45° field of view — 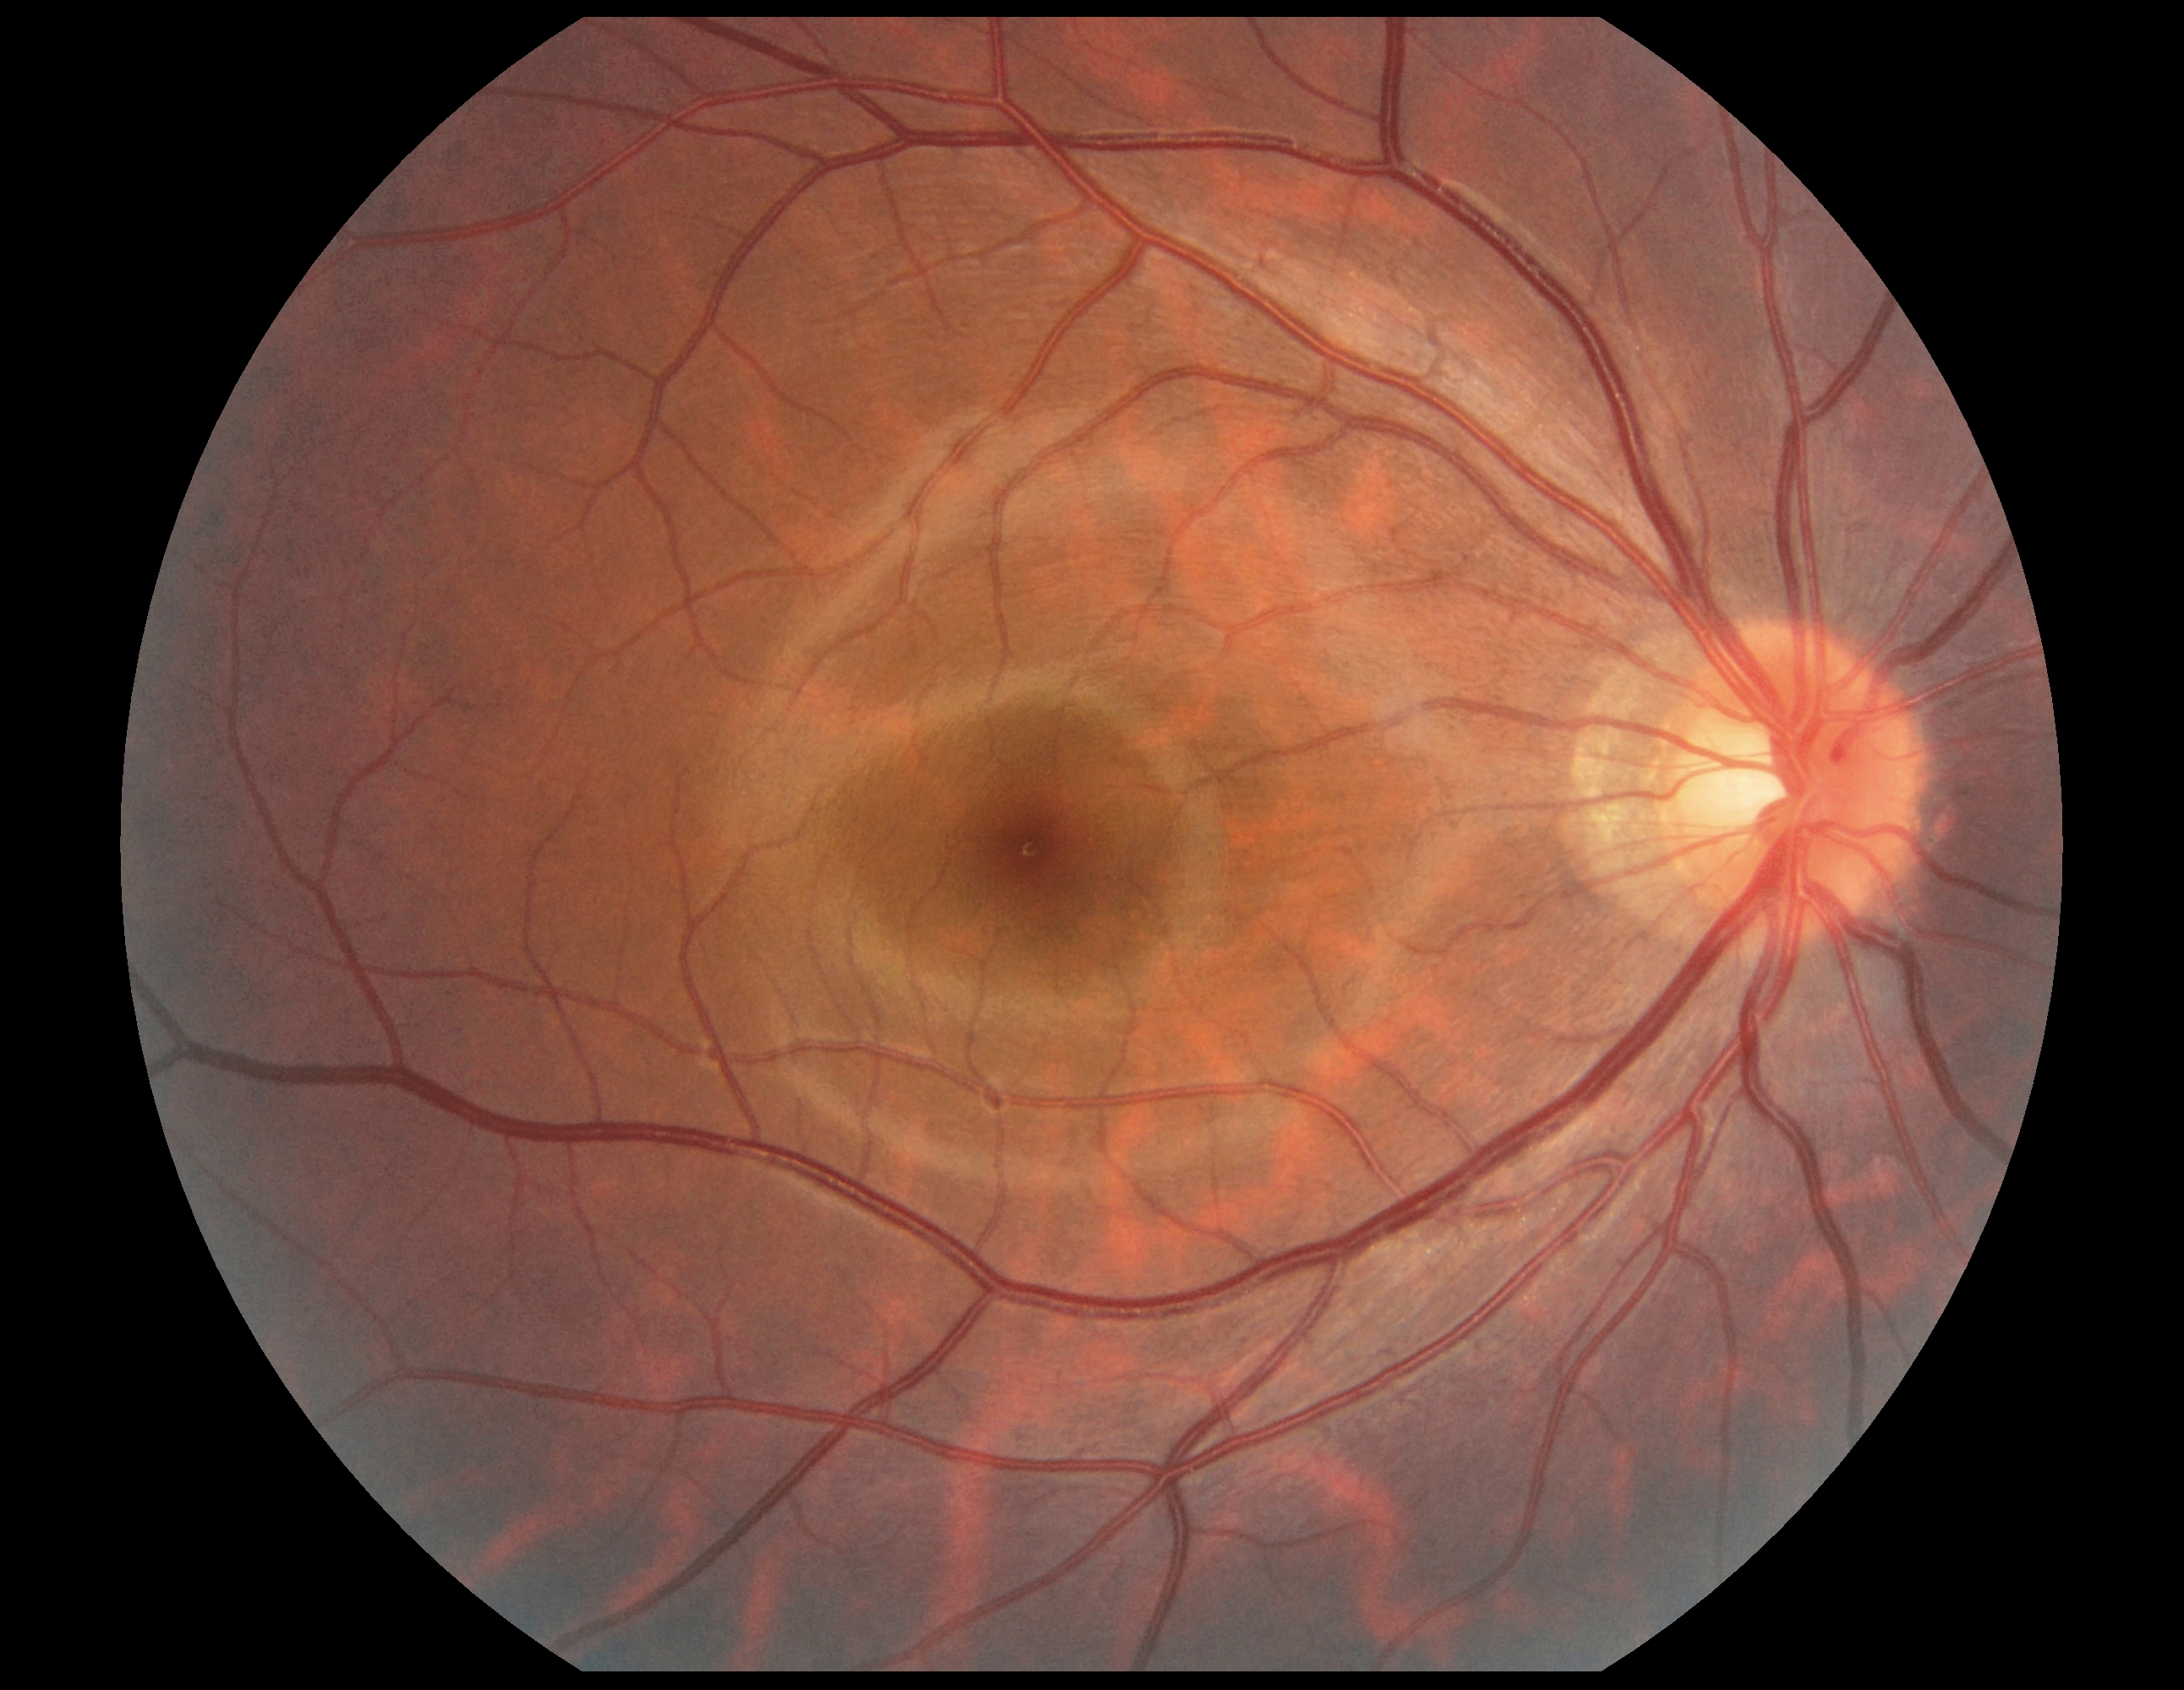
DR severity is grade 0.